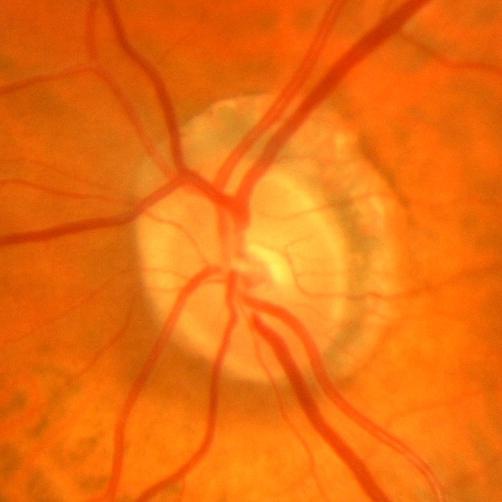 Impression: no evidence of glaucoma.